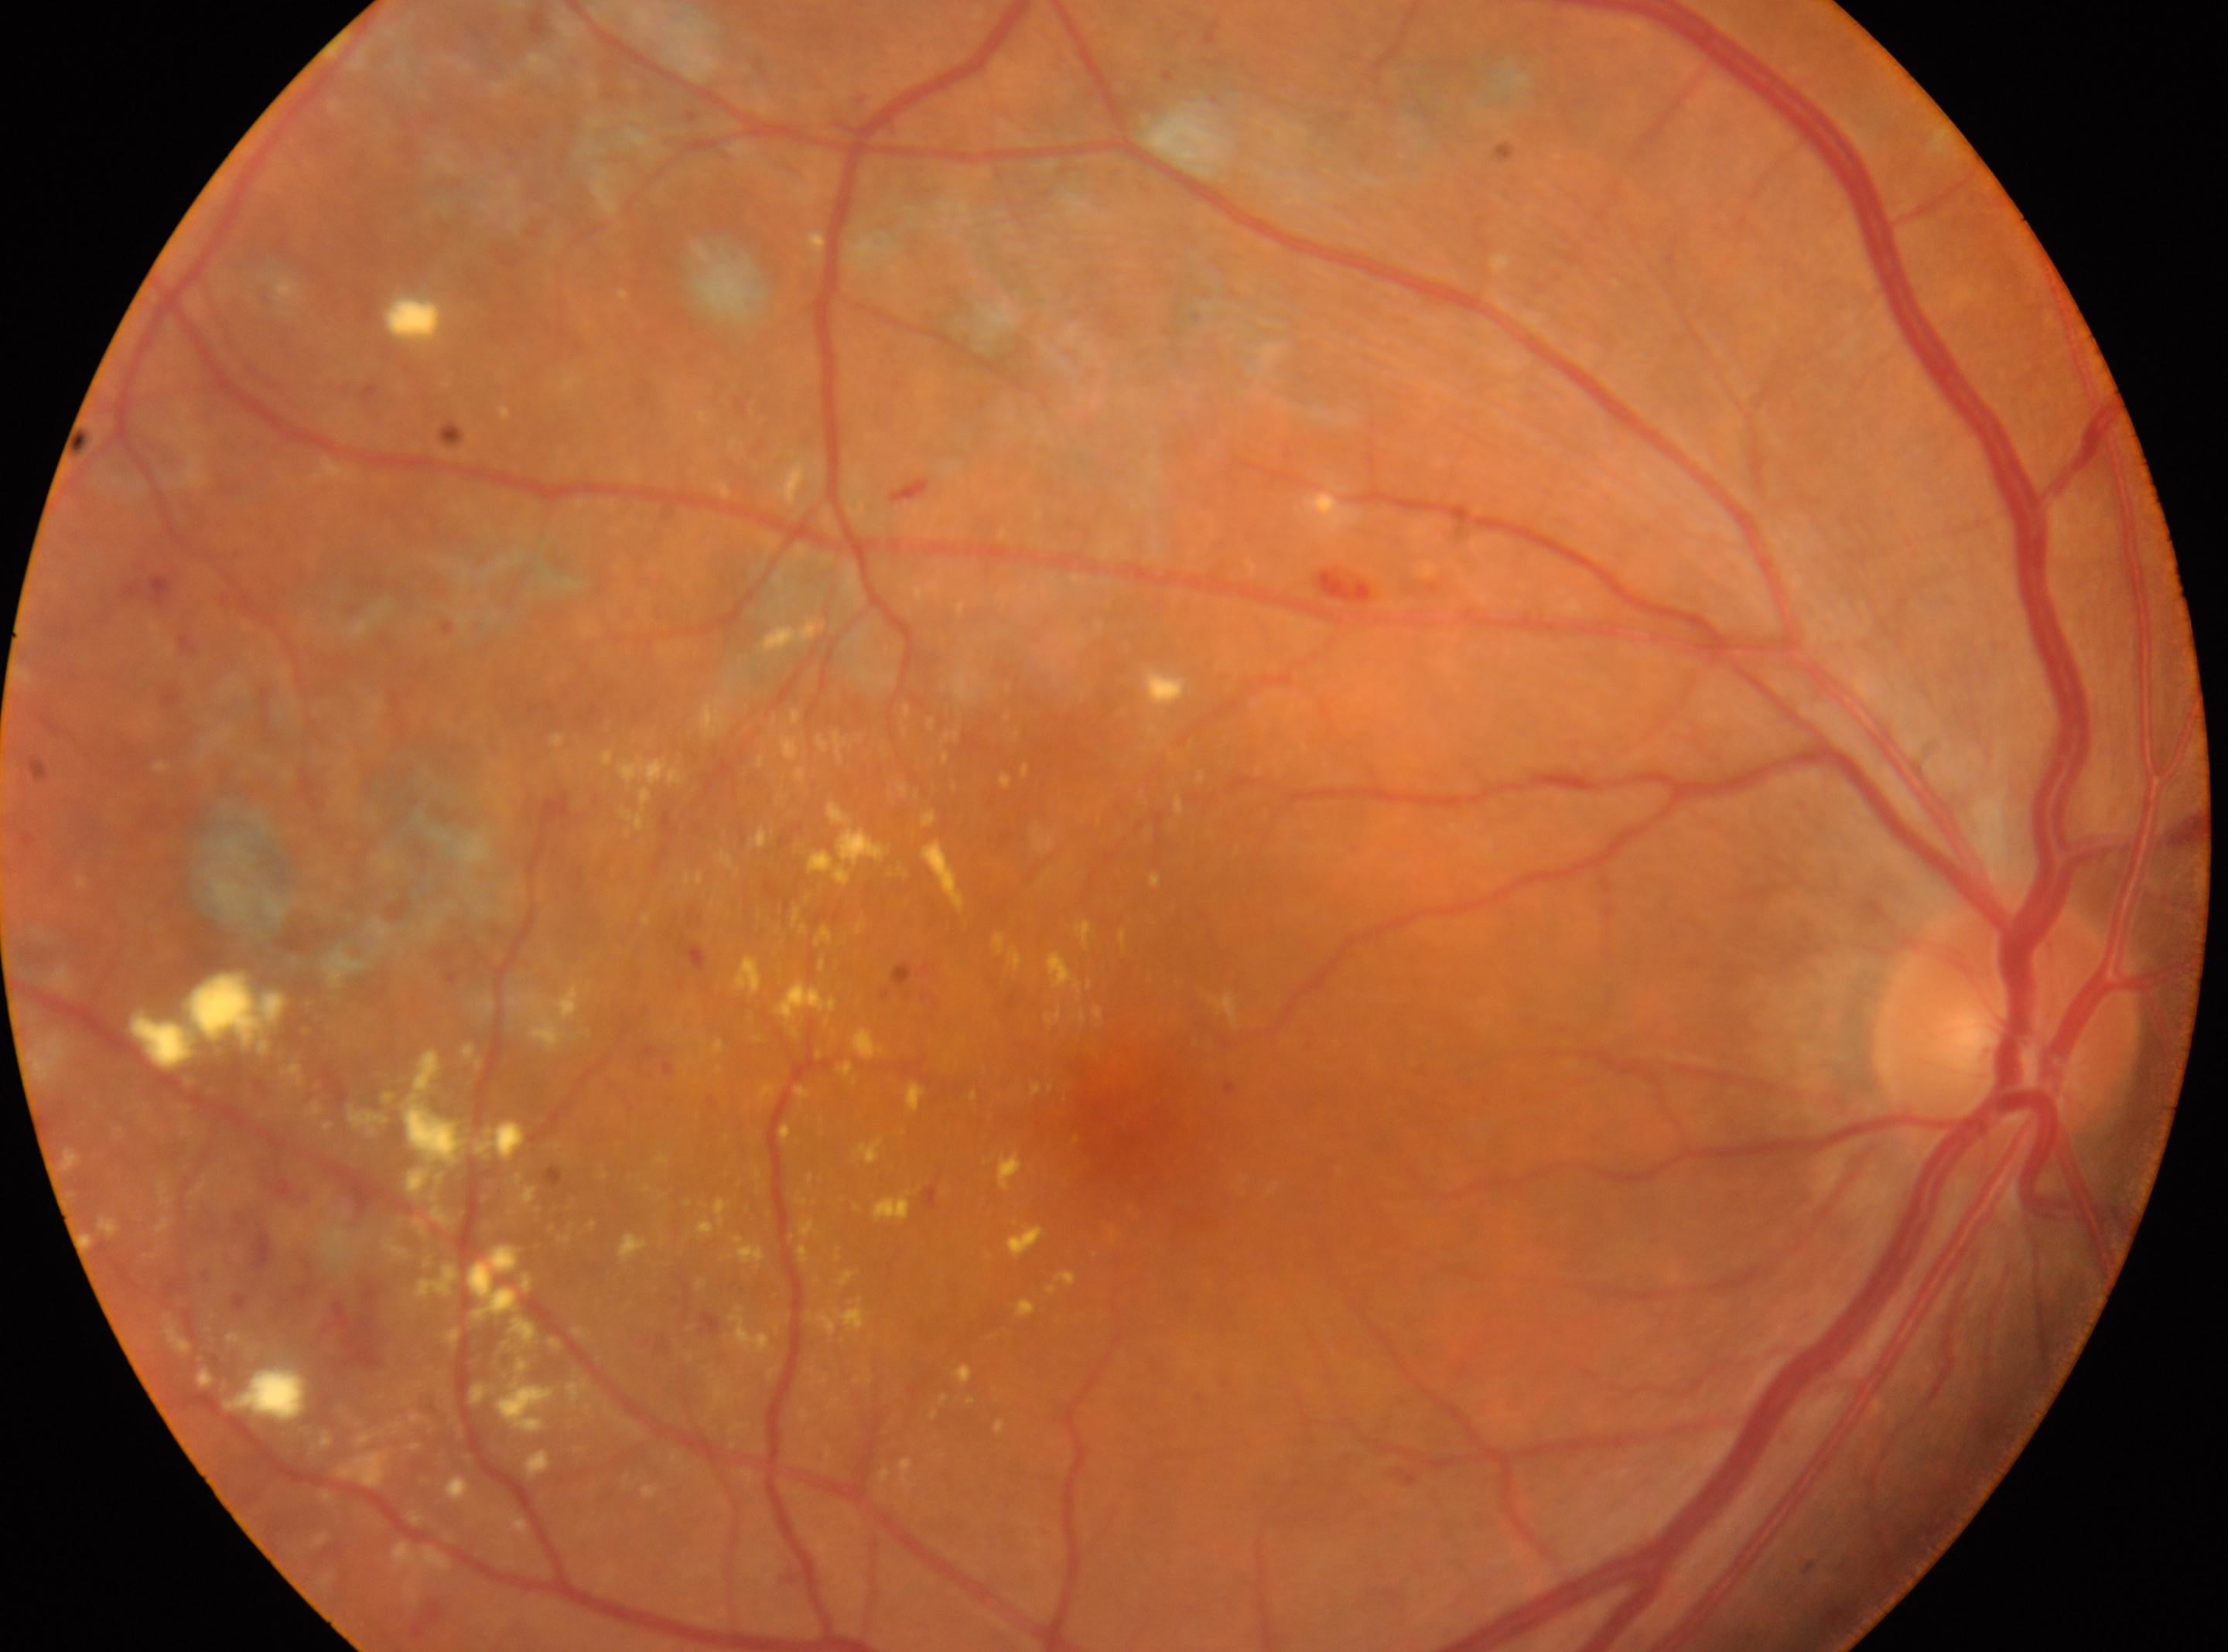 retinopathy grade: DR with laser photocoagulation scars
the optic disc: x=2004, y=1030
laterality: the right eye
the fovea: x=1126, y=1132